1932 by 1932 pixels, CFP:
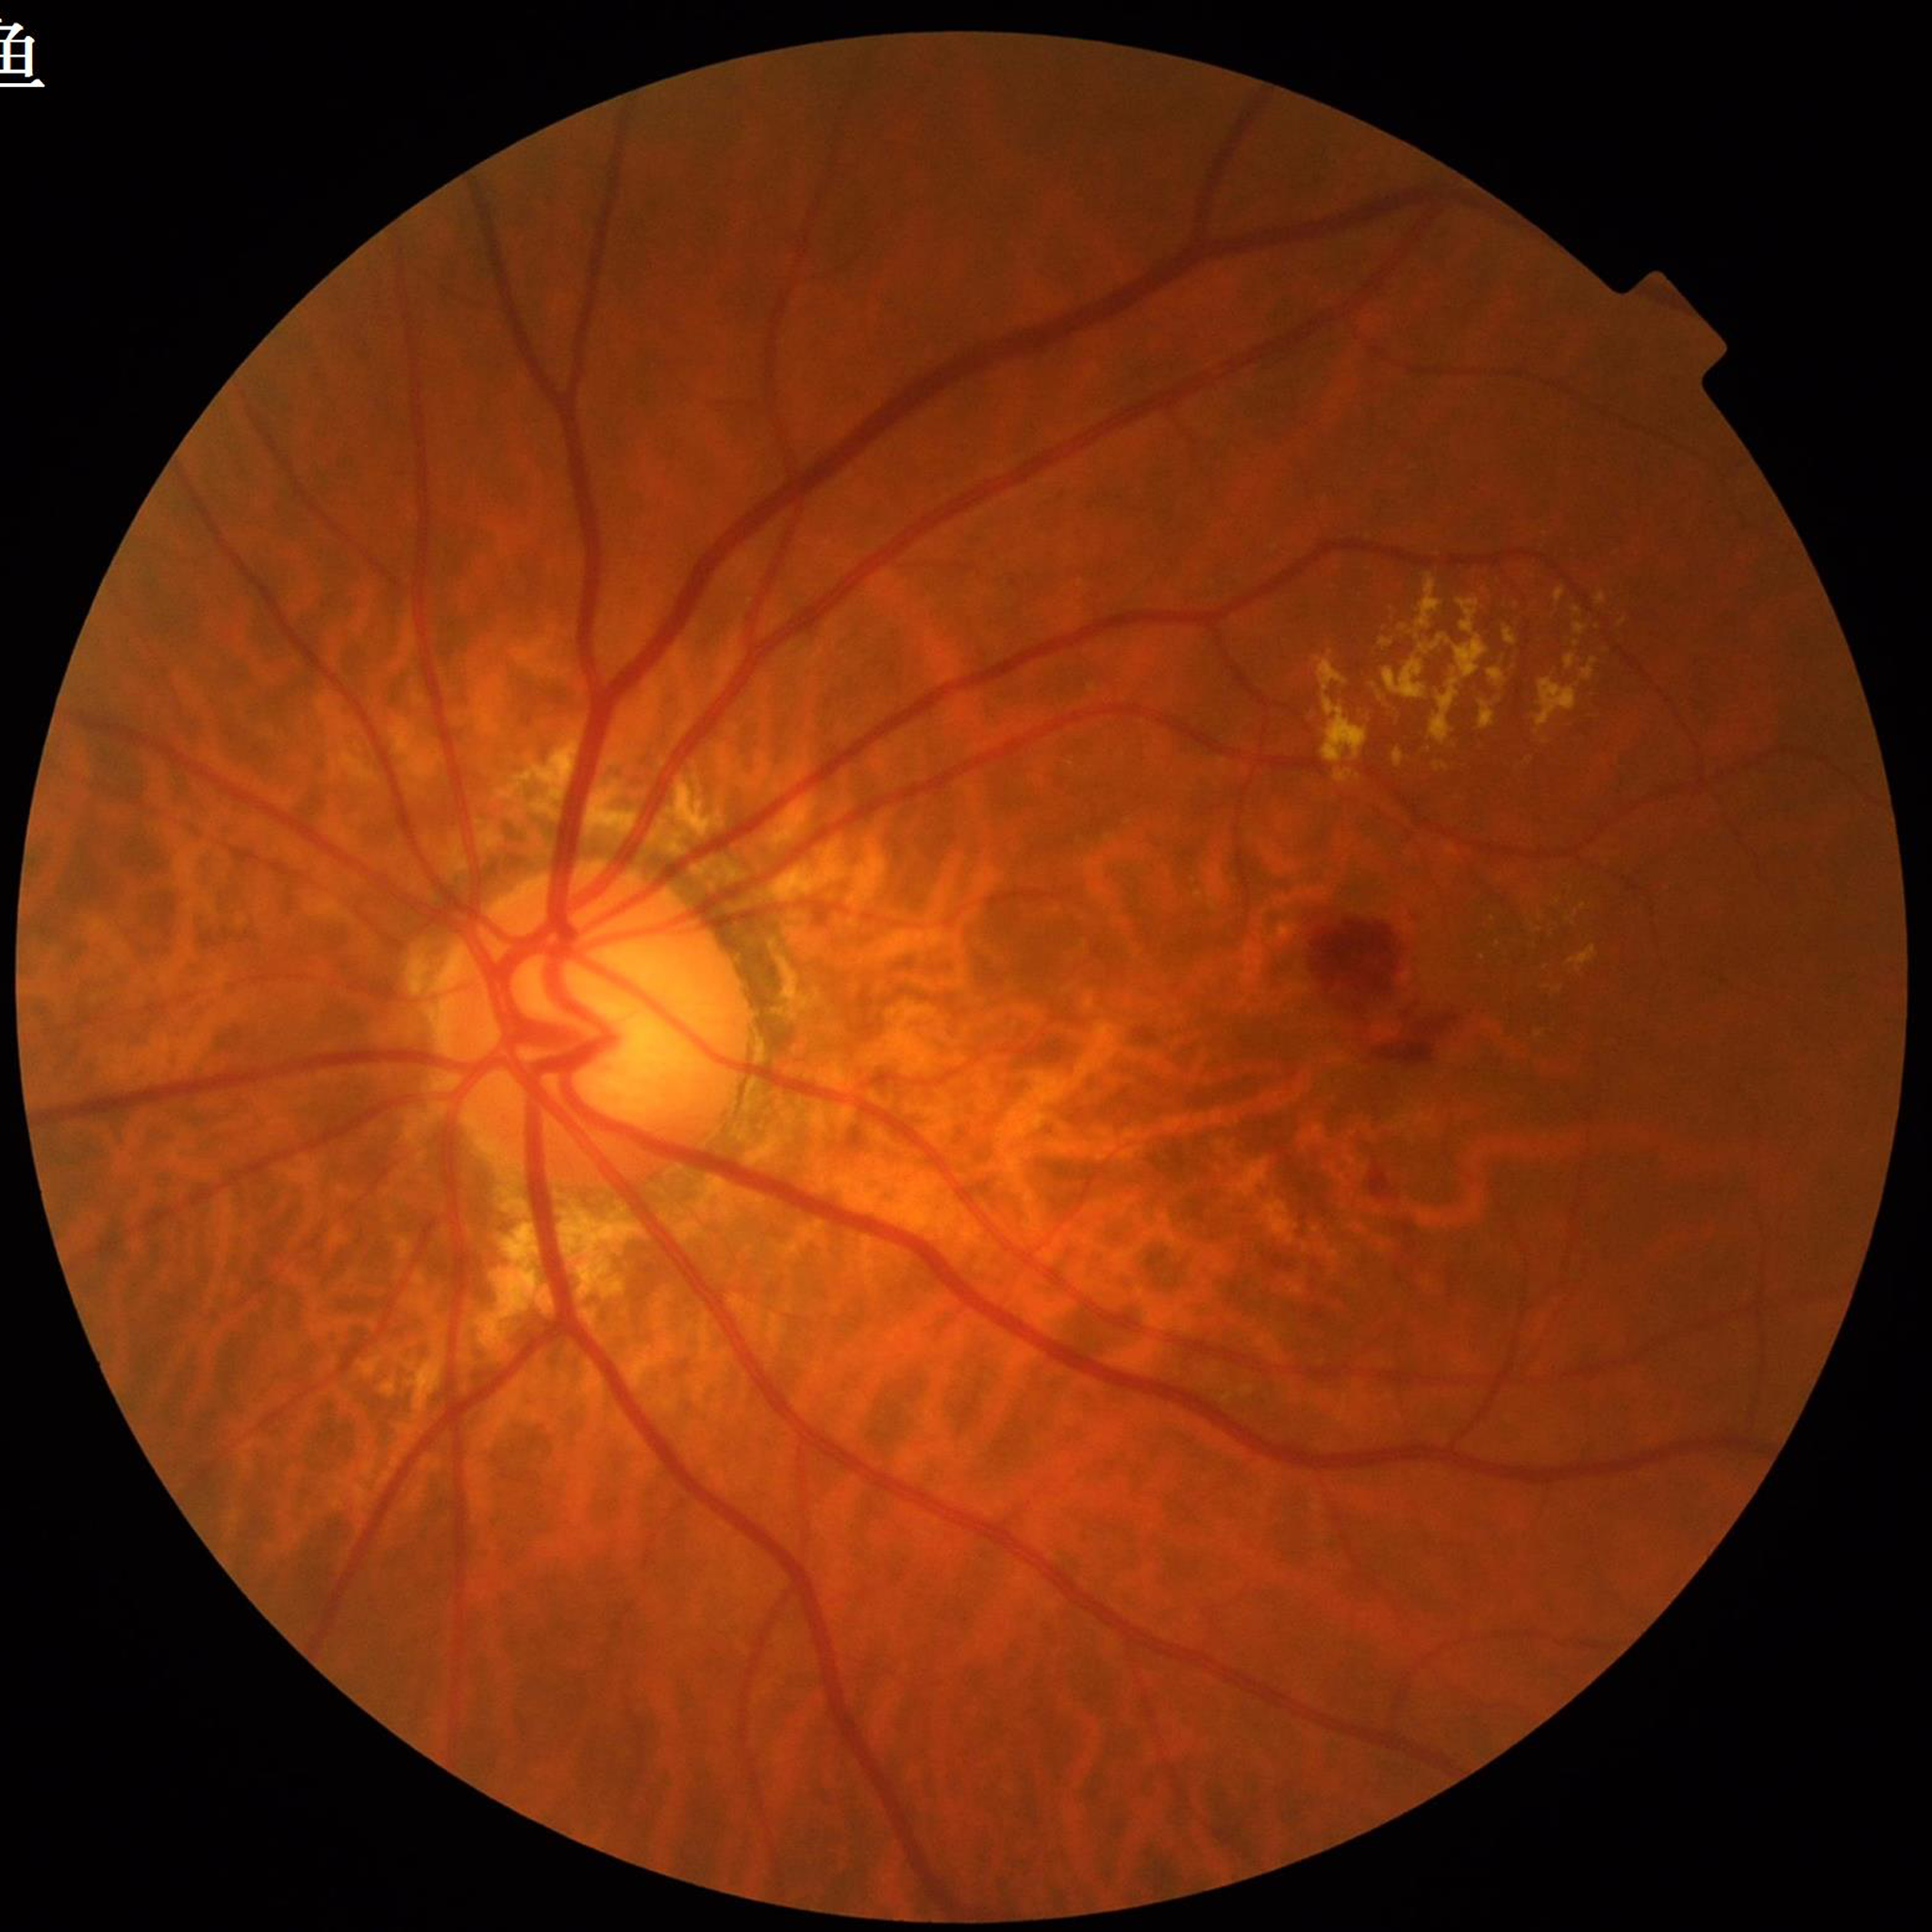 Automated quality assessment: no blur, contrast adequate, illumination and color satisfactory; Impression: age-related macular degeneration.